NIDEK AFC-230 fundus camera · 848 x 848 pixels: 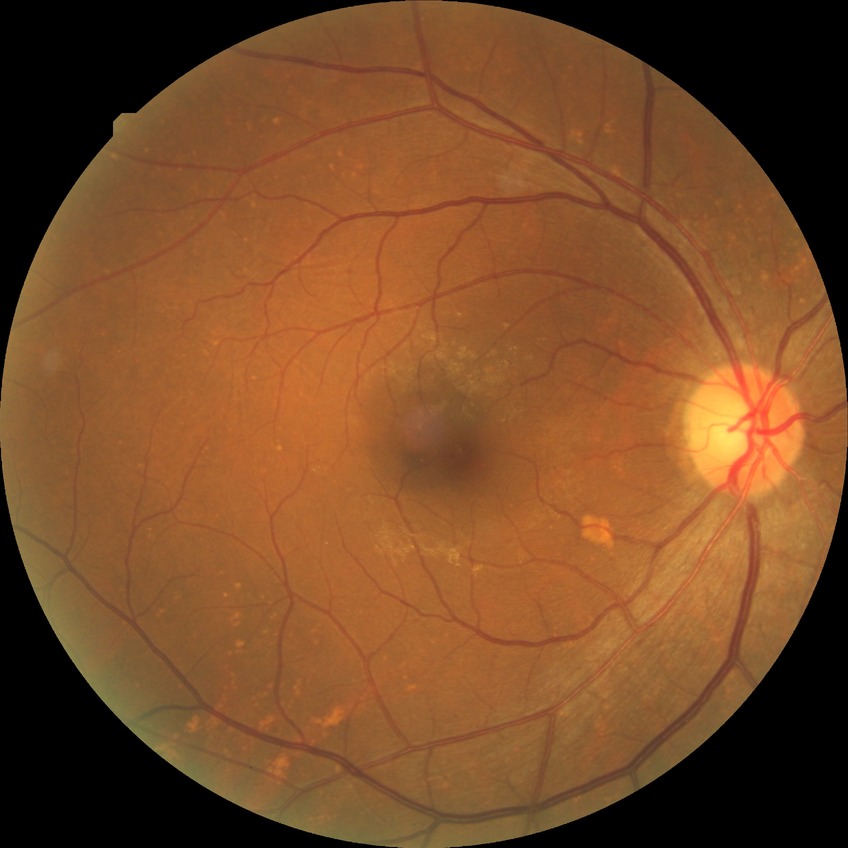

Davis grading = no diabetic retinopathy.